Diabetic retinopathy graded by the modified Davis classification:
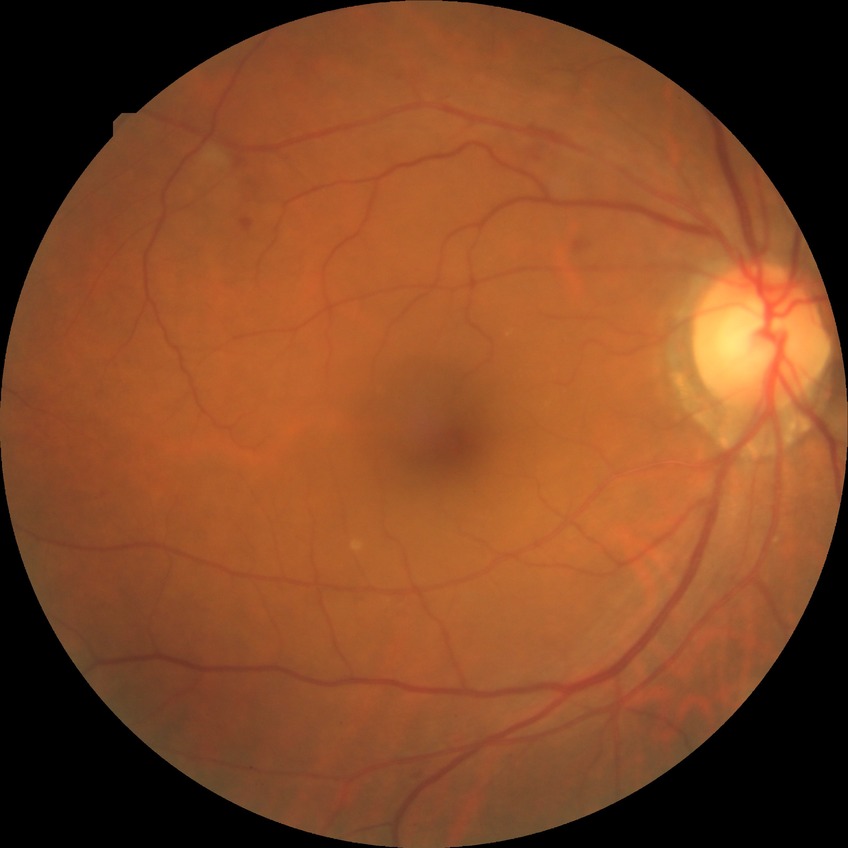
{
  "davis_grade": "pre-proliferative diabetic retinopathy (PPDR)"
}